Color fundus photograph · 45° field of view · image size 848x848 · Davis DR grading: 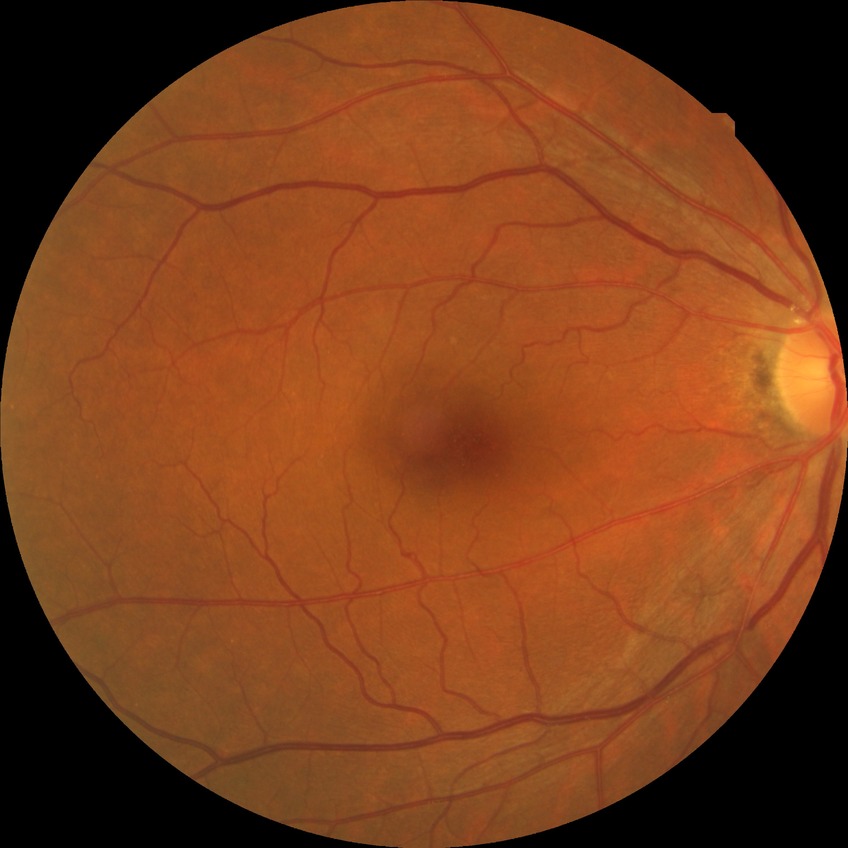 Davis grade = NDR.